2212 x 1659 pixels · color fundus photograph from a handheld portable camera · 60-degree field of view.
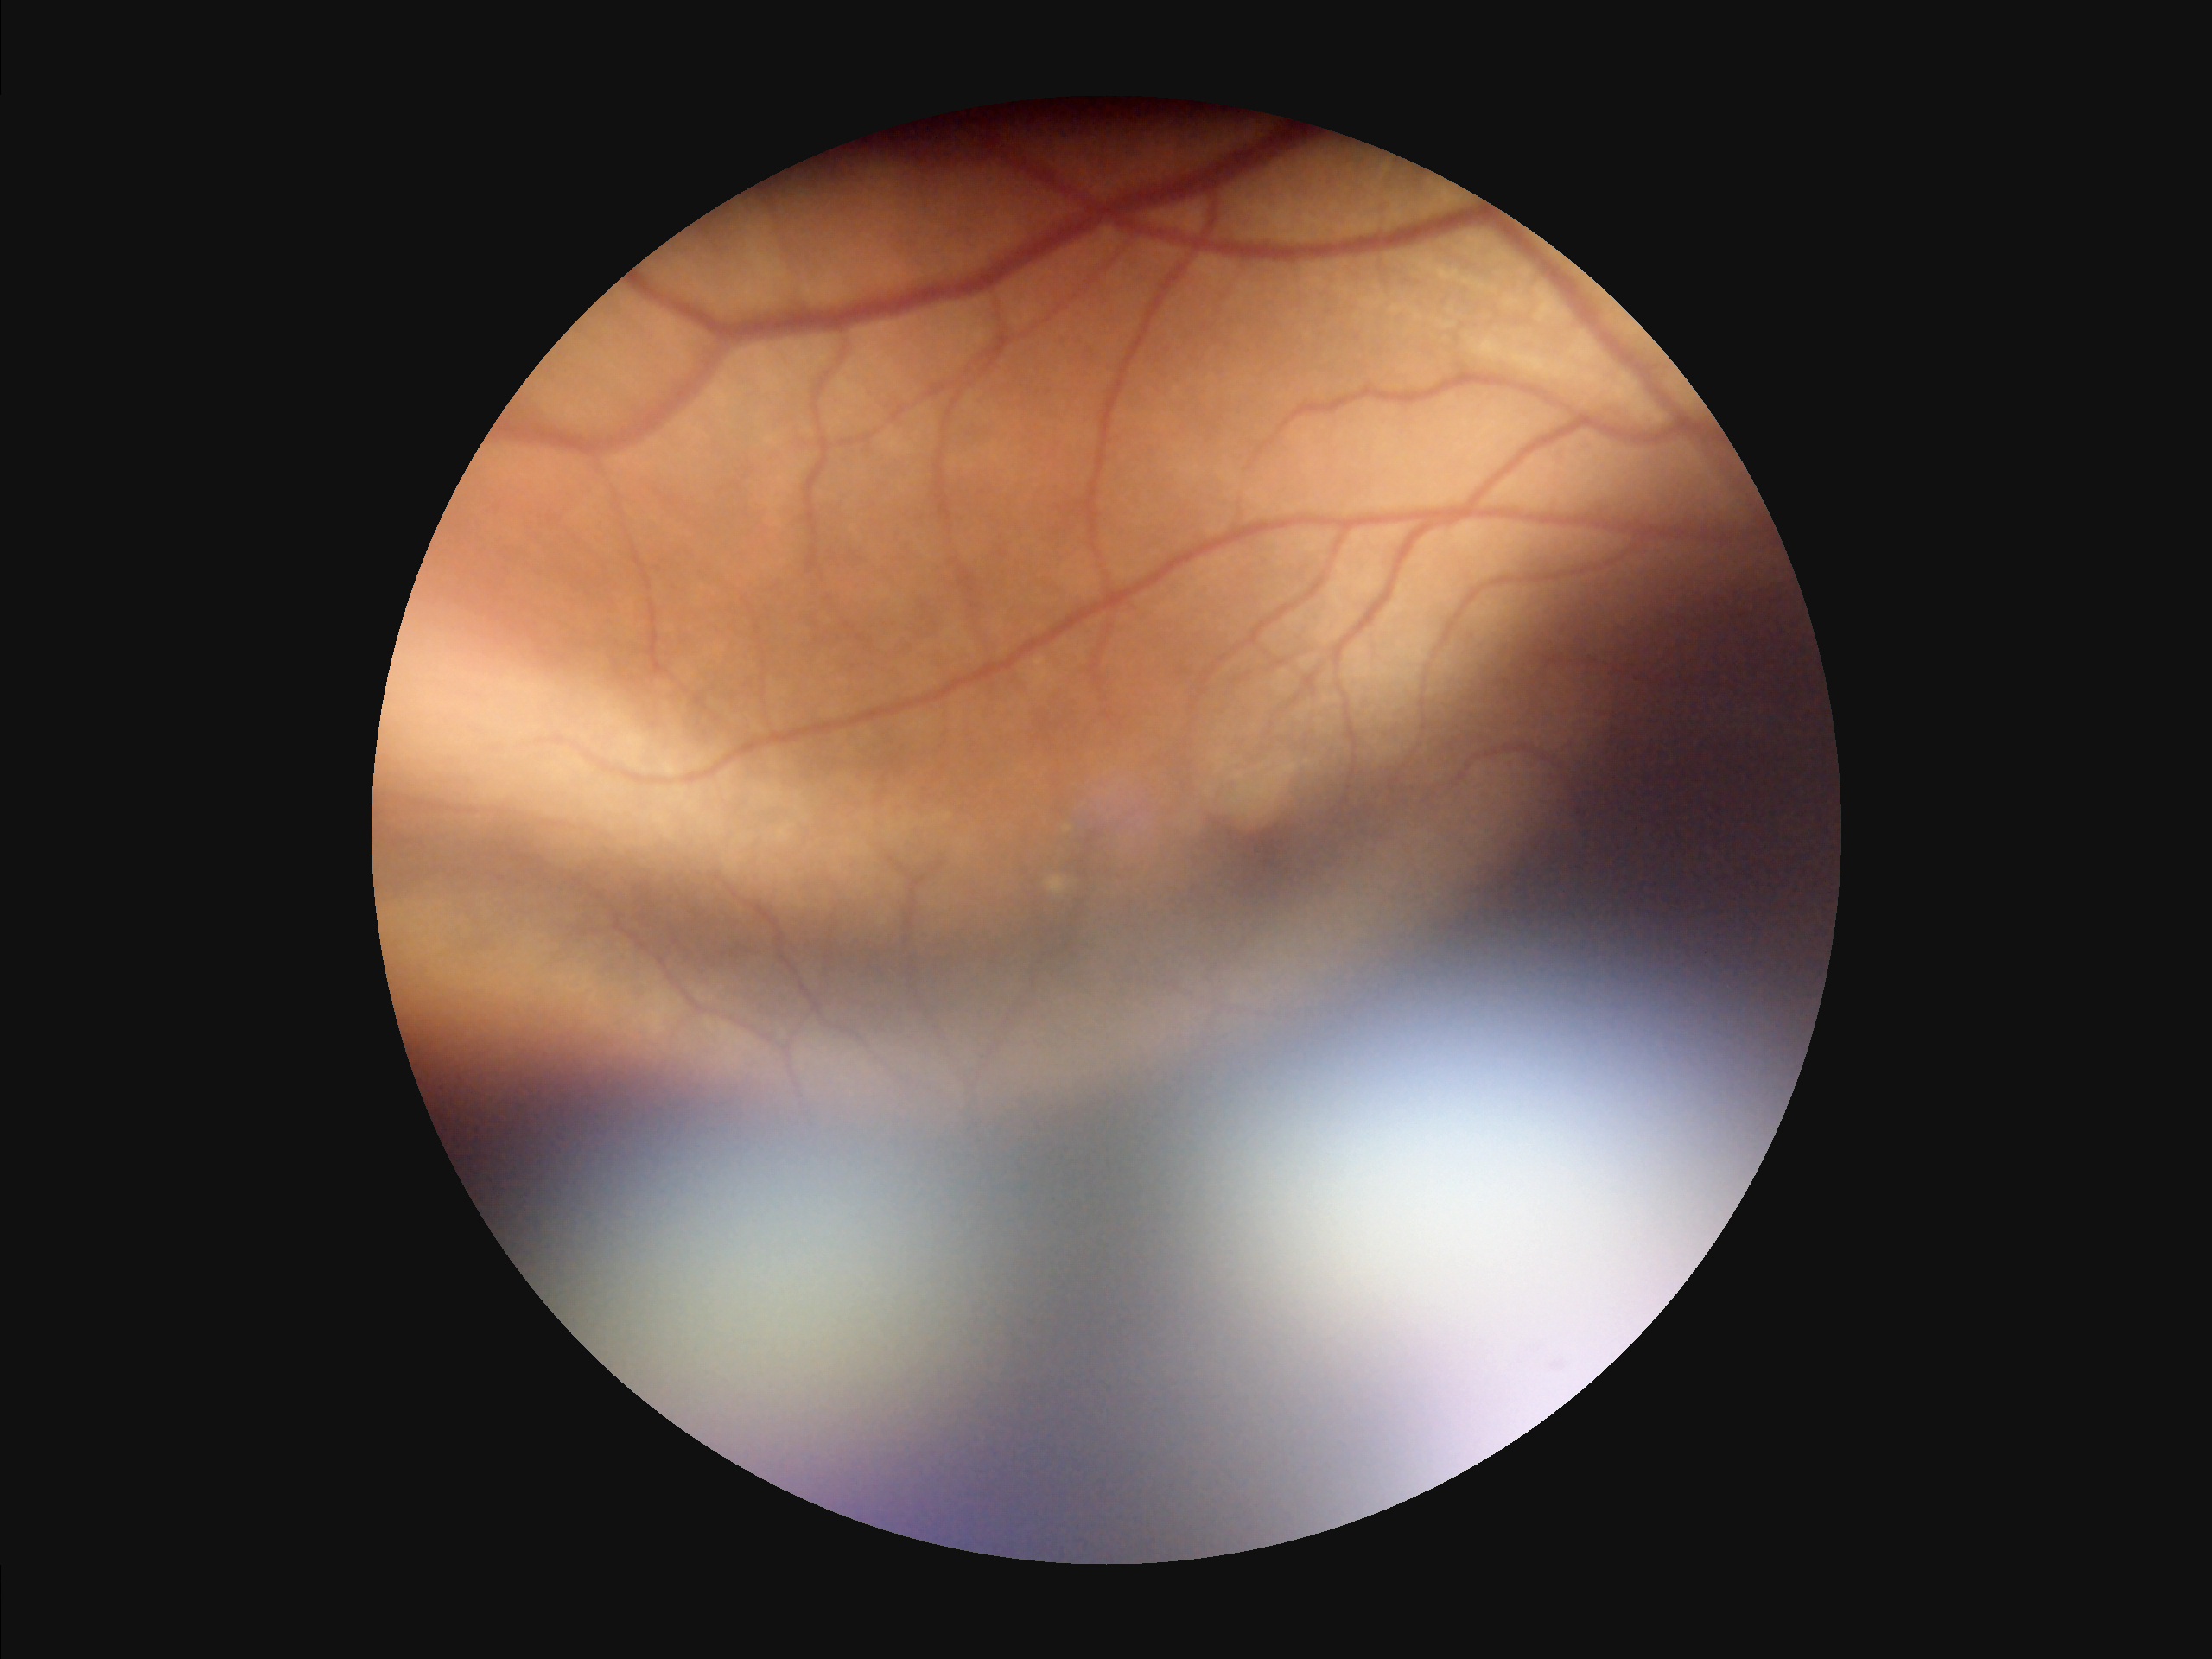
There is over- or under-exposure or a color cast. Noticeable blur in the optic disc, vessels, or background. Overall quality is poor; the image is difficult to grade. Vessels and details are readily distinguishable.